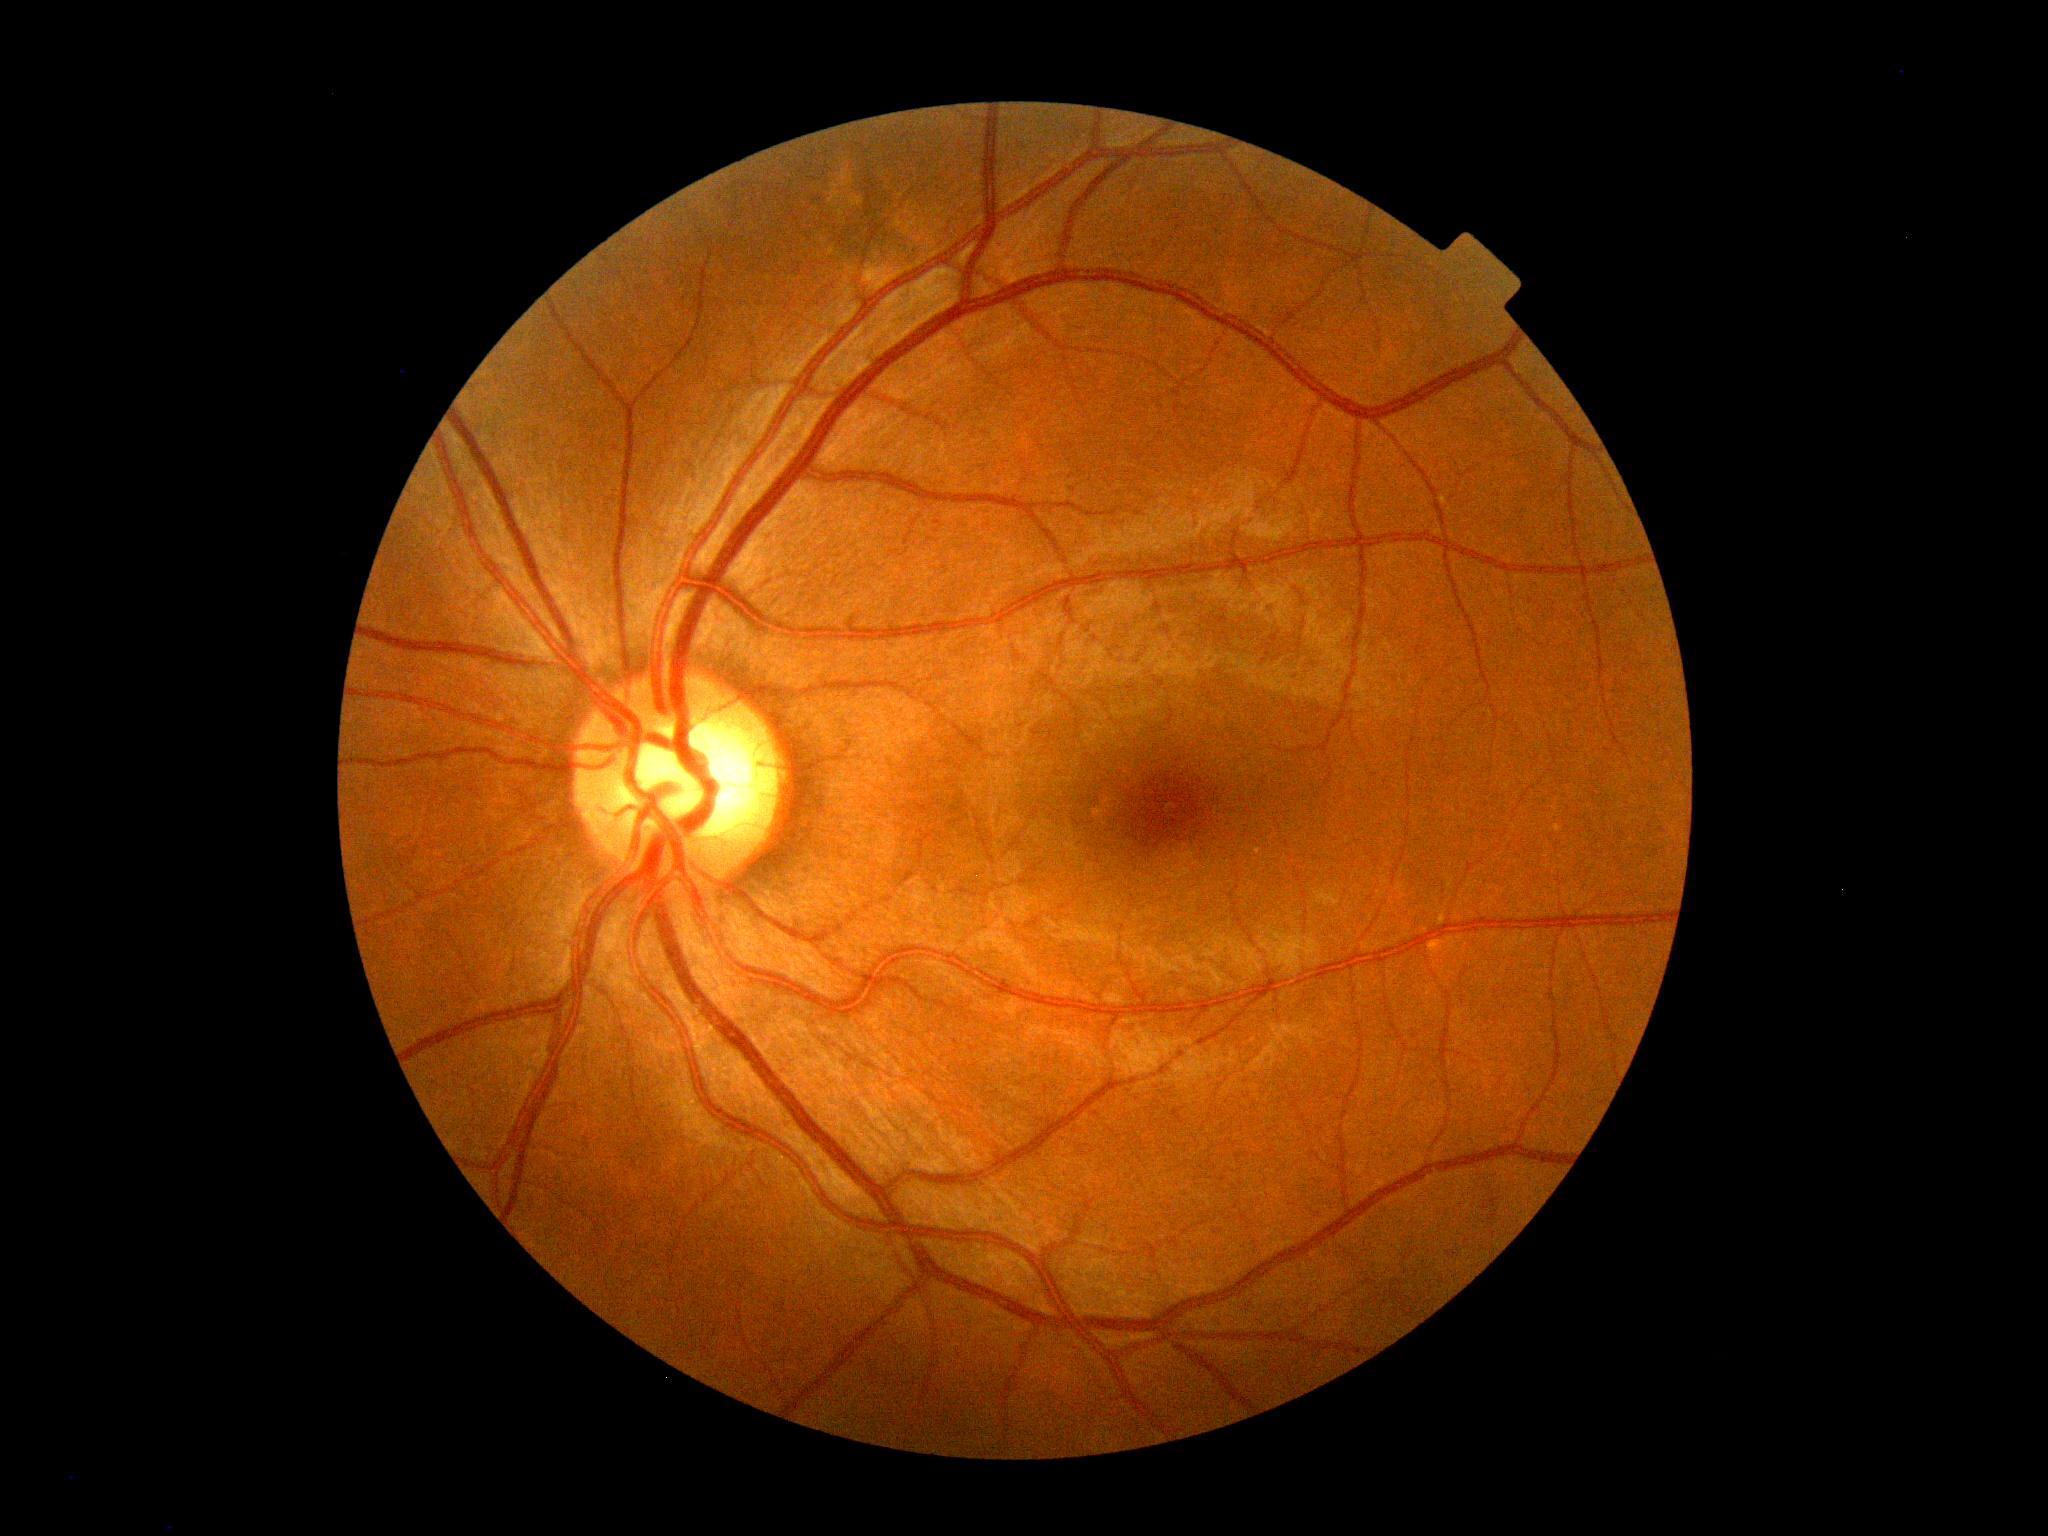
Diabetic retinopathy (DR) is 0/4.